Image size 2352x1568: 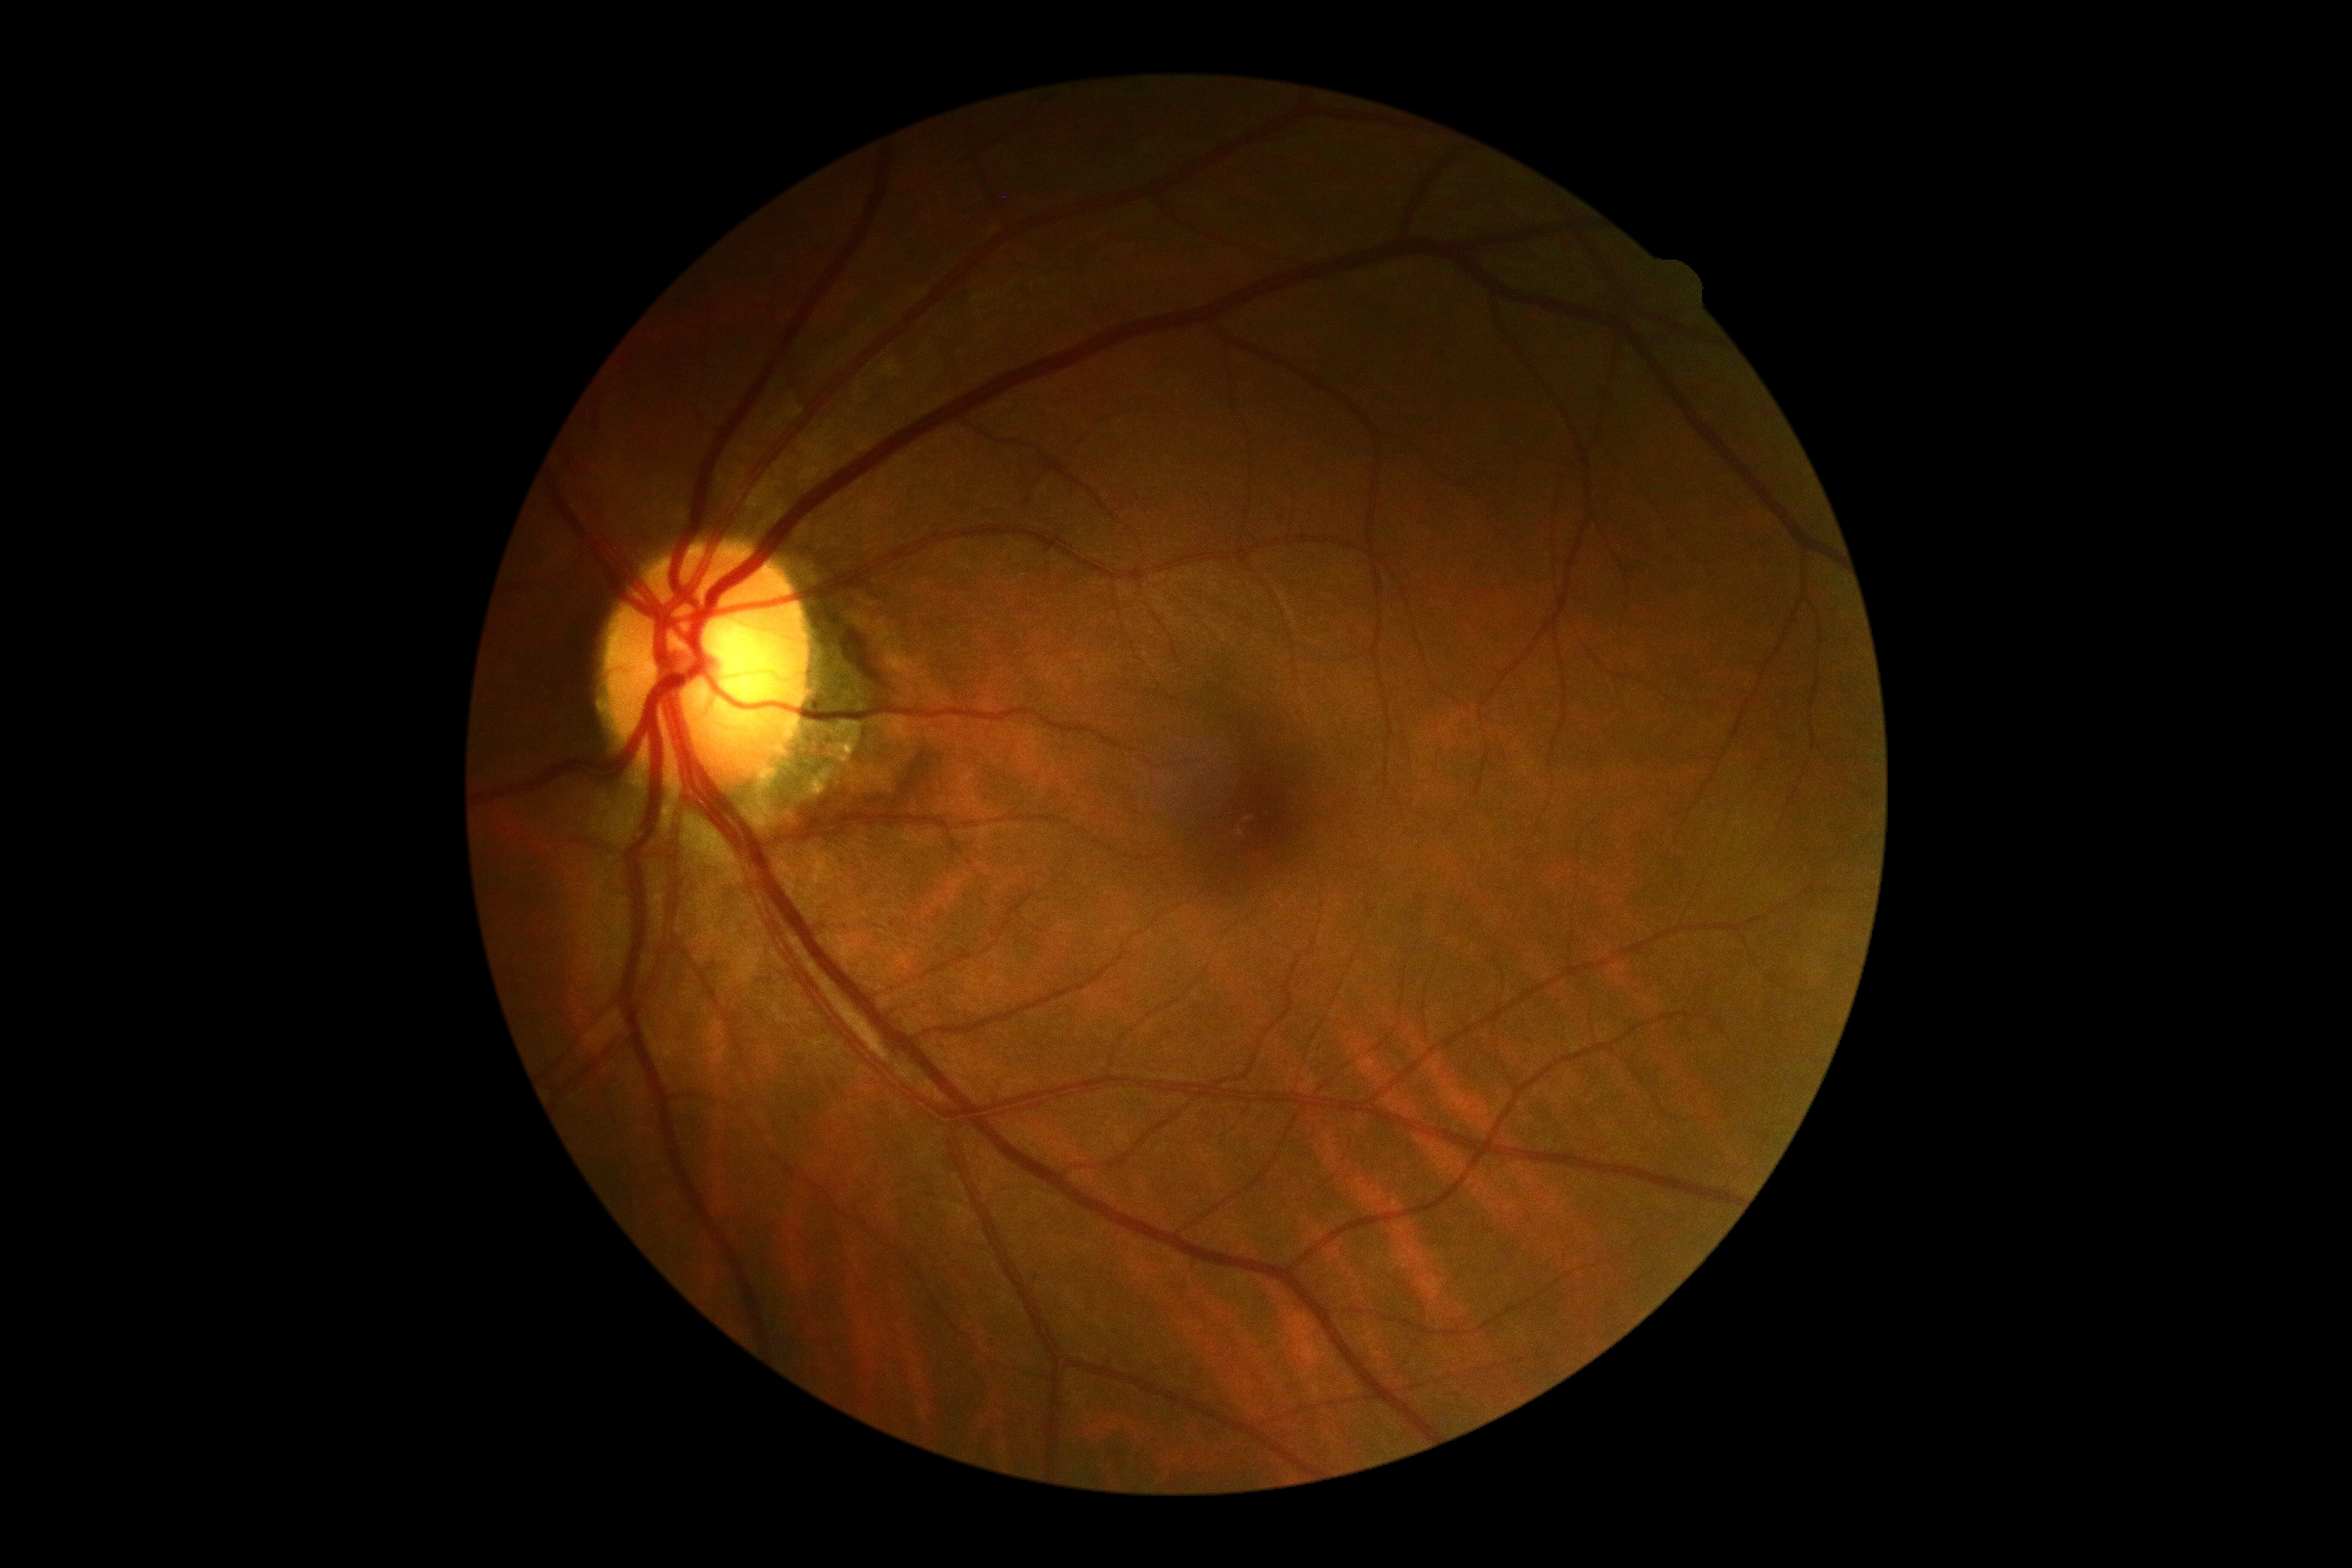

diabetic retinopathy (DR): 0.